Infant wide-field retinal image: 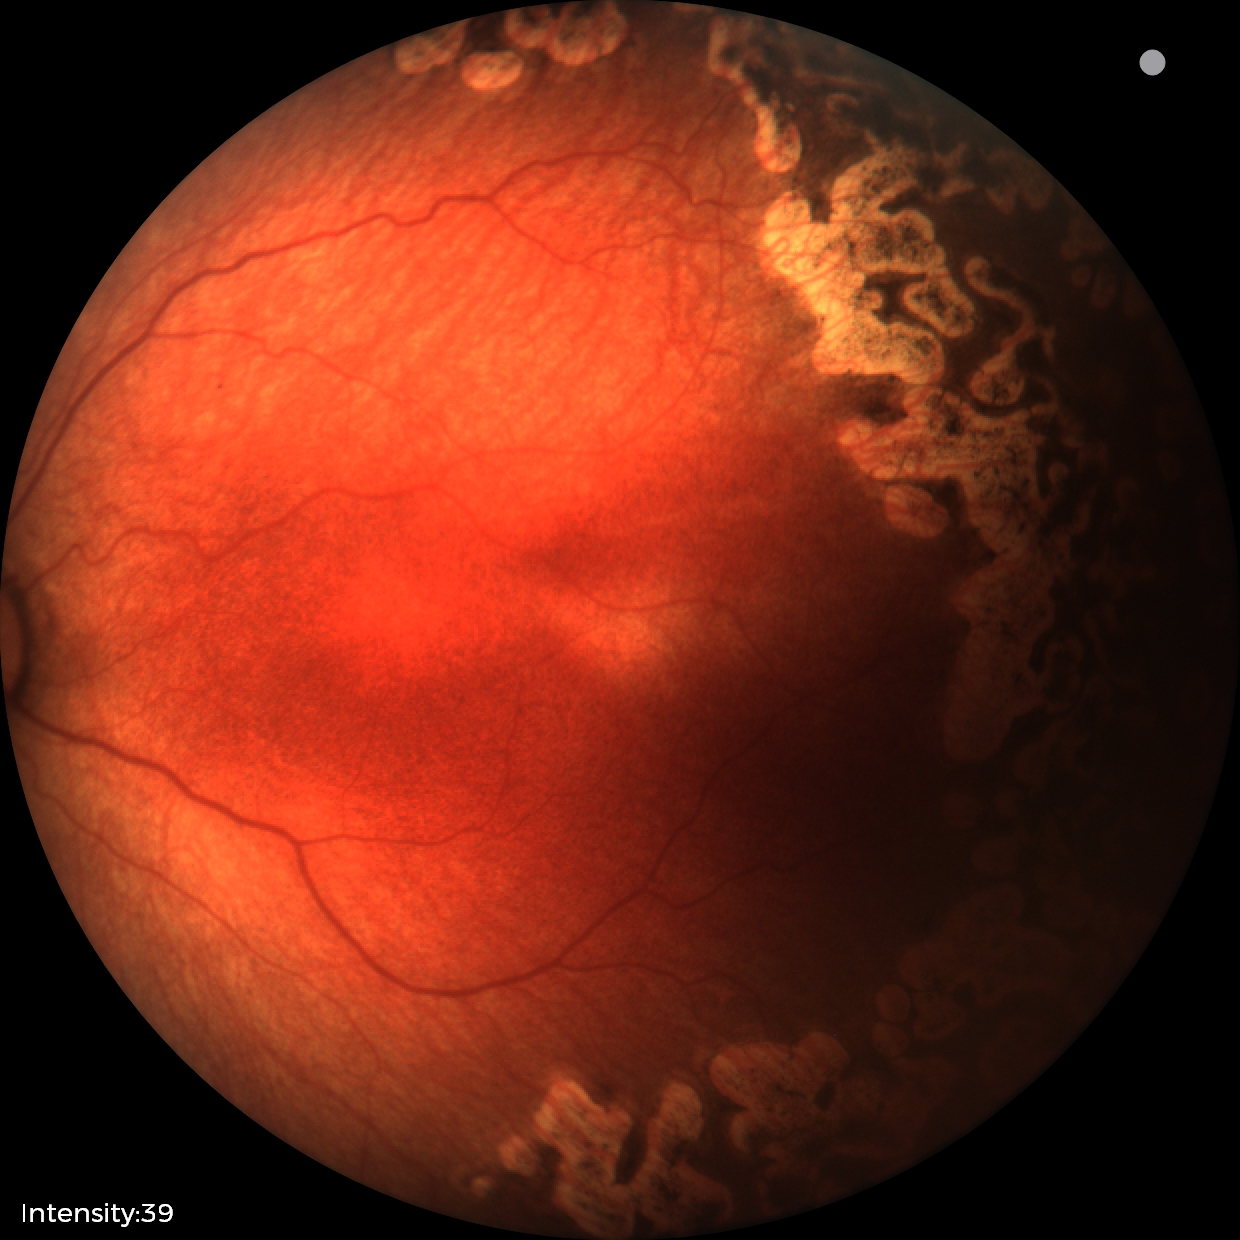
Series diagnosed as status post retinopathy of prematurity.
No plus disease.